1659 by 2212 pixels, captured on a Remidio Fundus on Phone (FOP) camera:
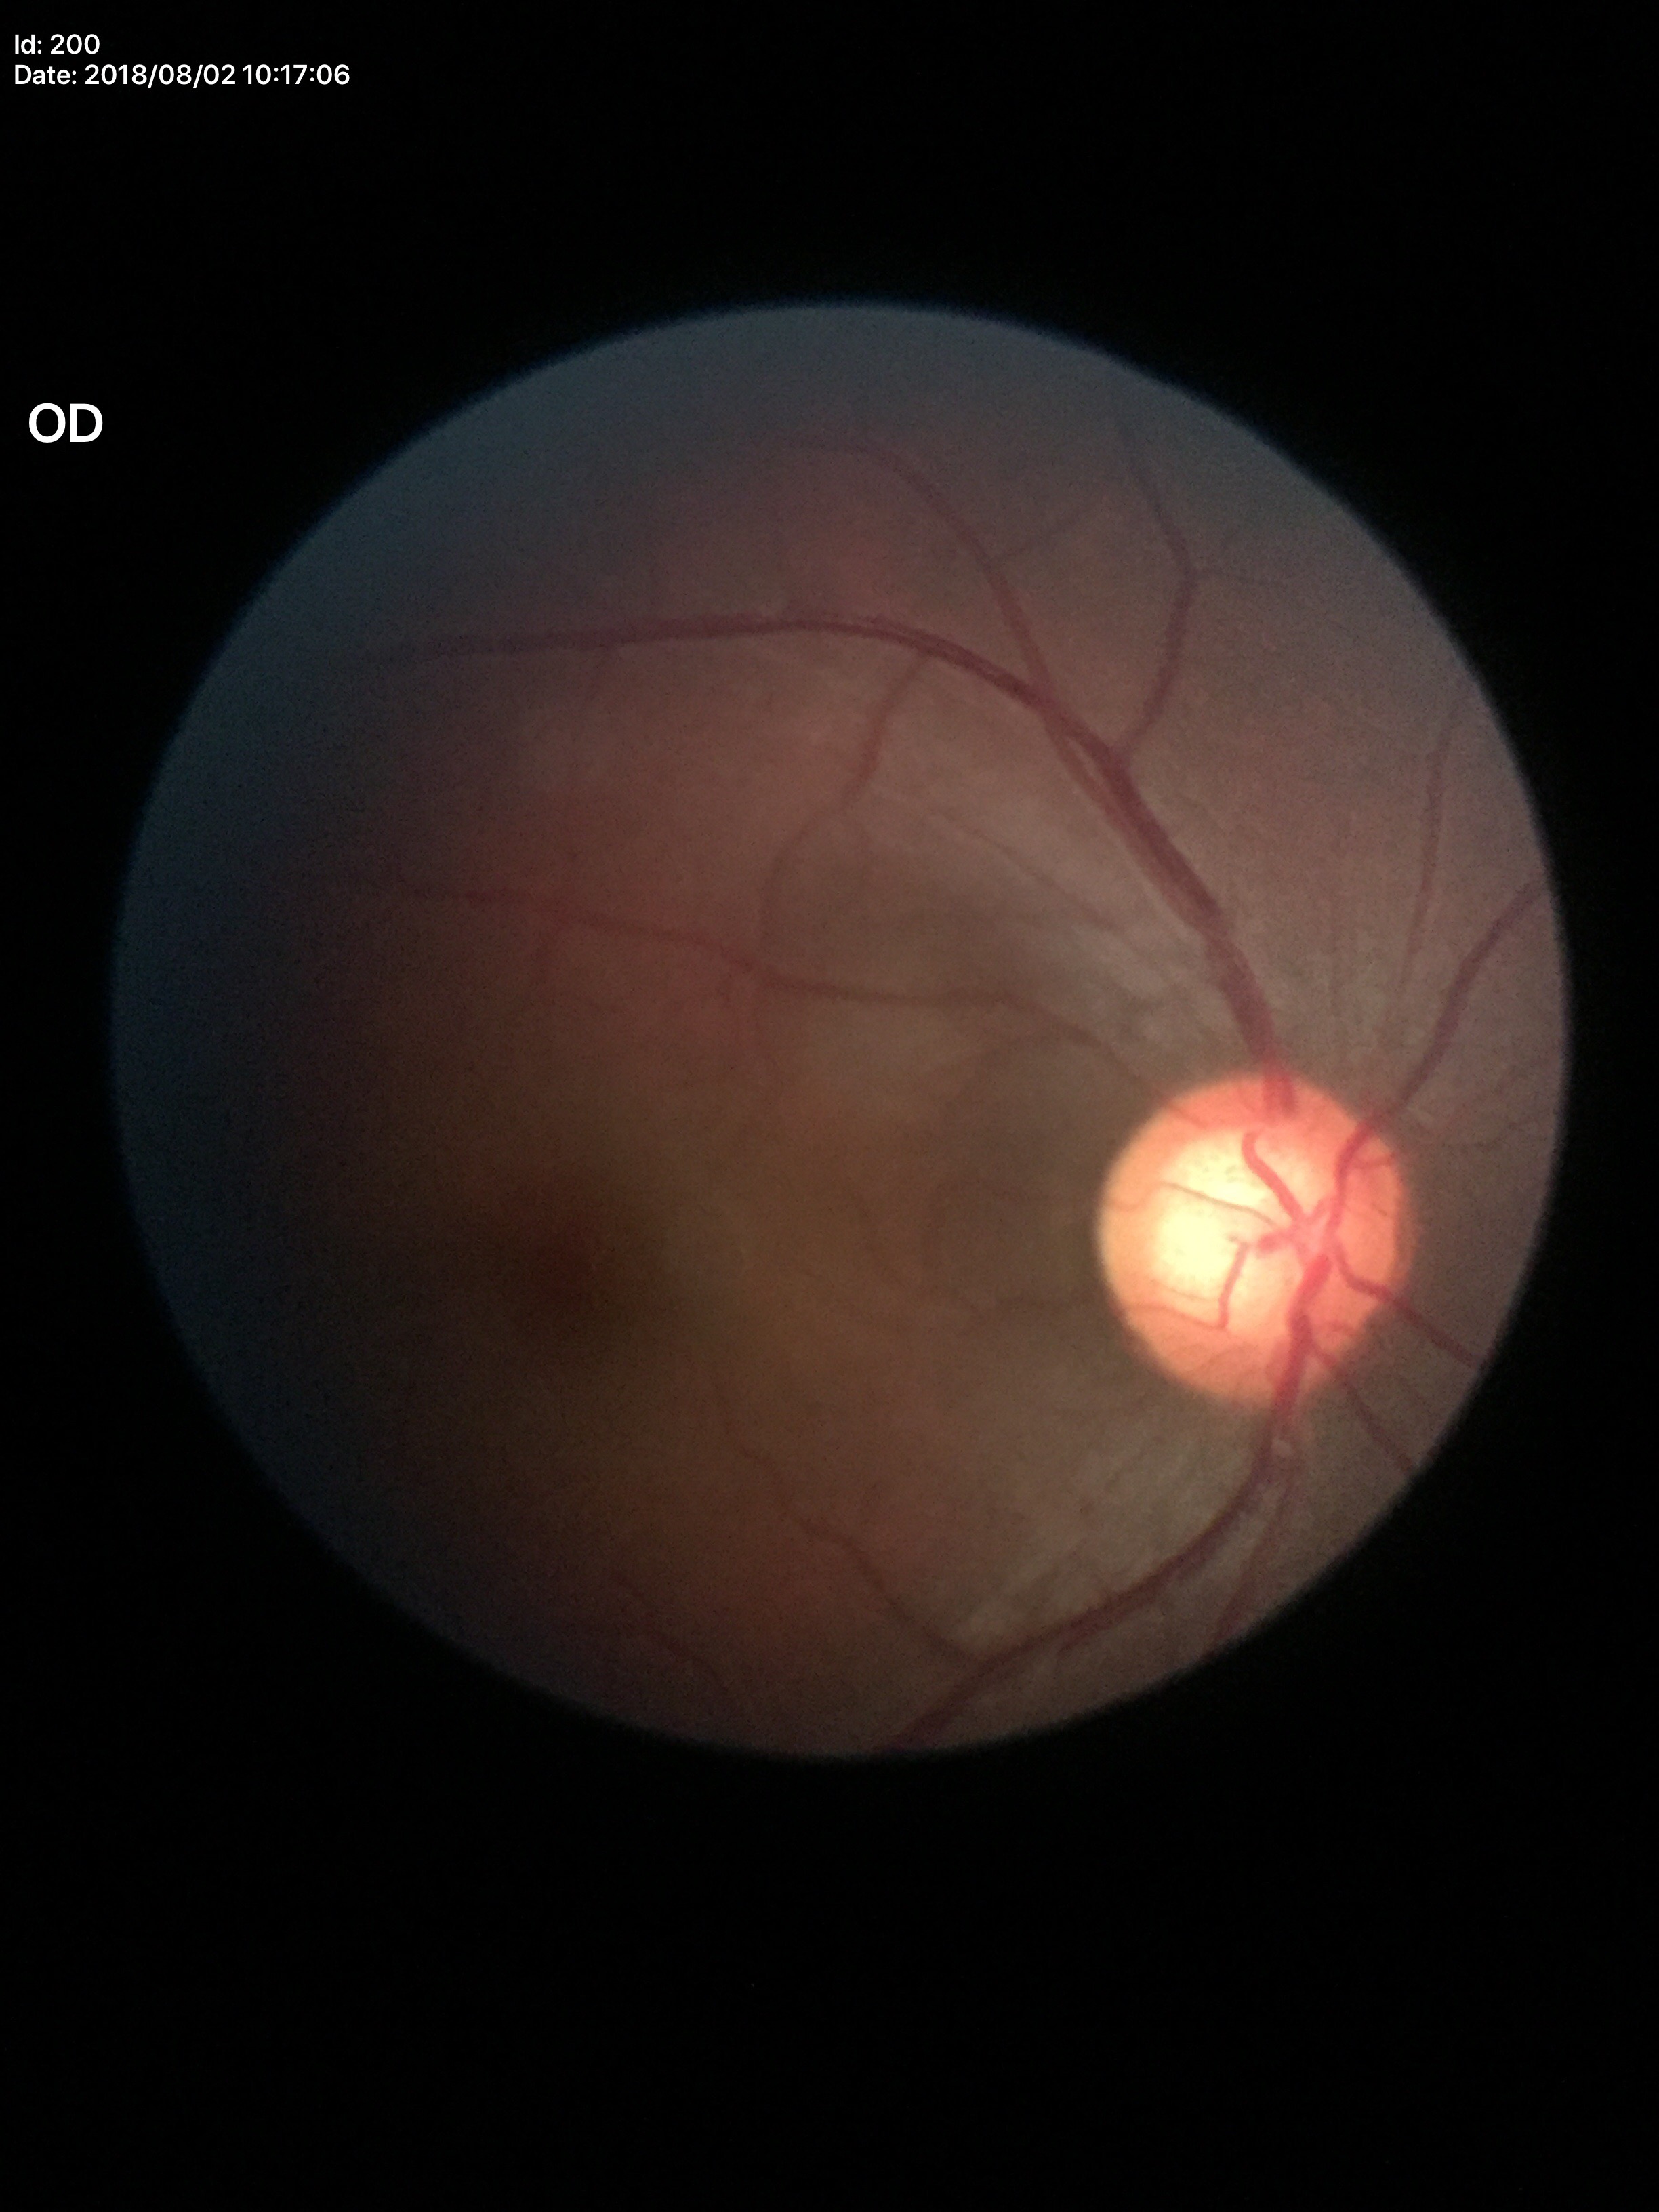

Glaucoma evaluation: suspect. Vertical cup-disc ratio of 0.71. Horizontal C/D ratio is 0.68.